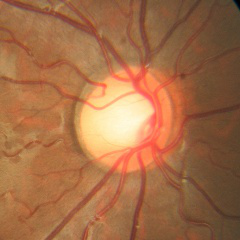 Glaucoma status: no evidence of glaucoma.